Wide-field fundus photograph from neonatal ROP screening
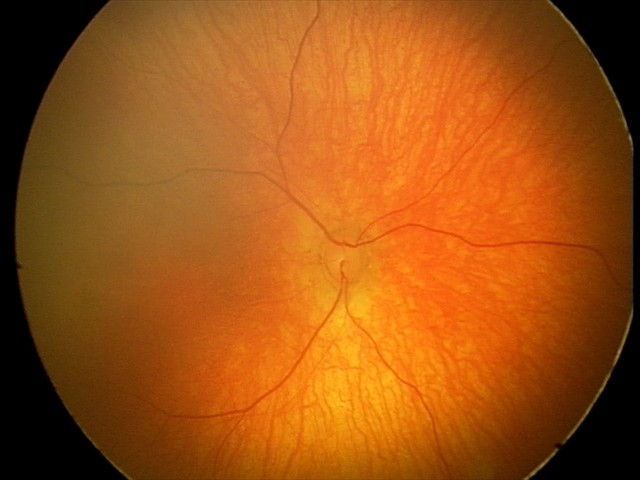
Screening: physiological finding.